Pediatric wide-field fundus photograph · 640x480
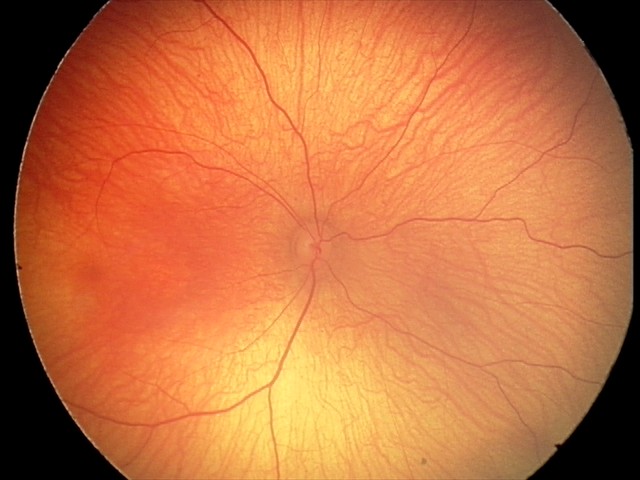

Physiological retinal appearance for postconceptual age.